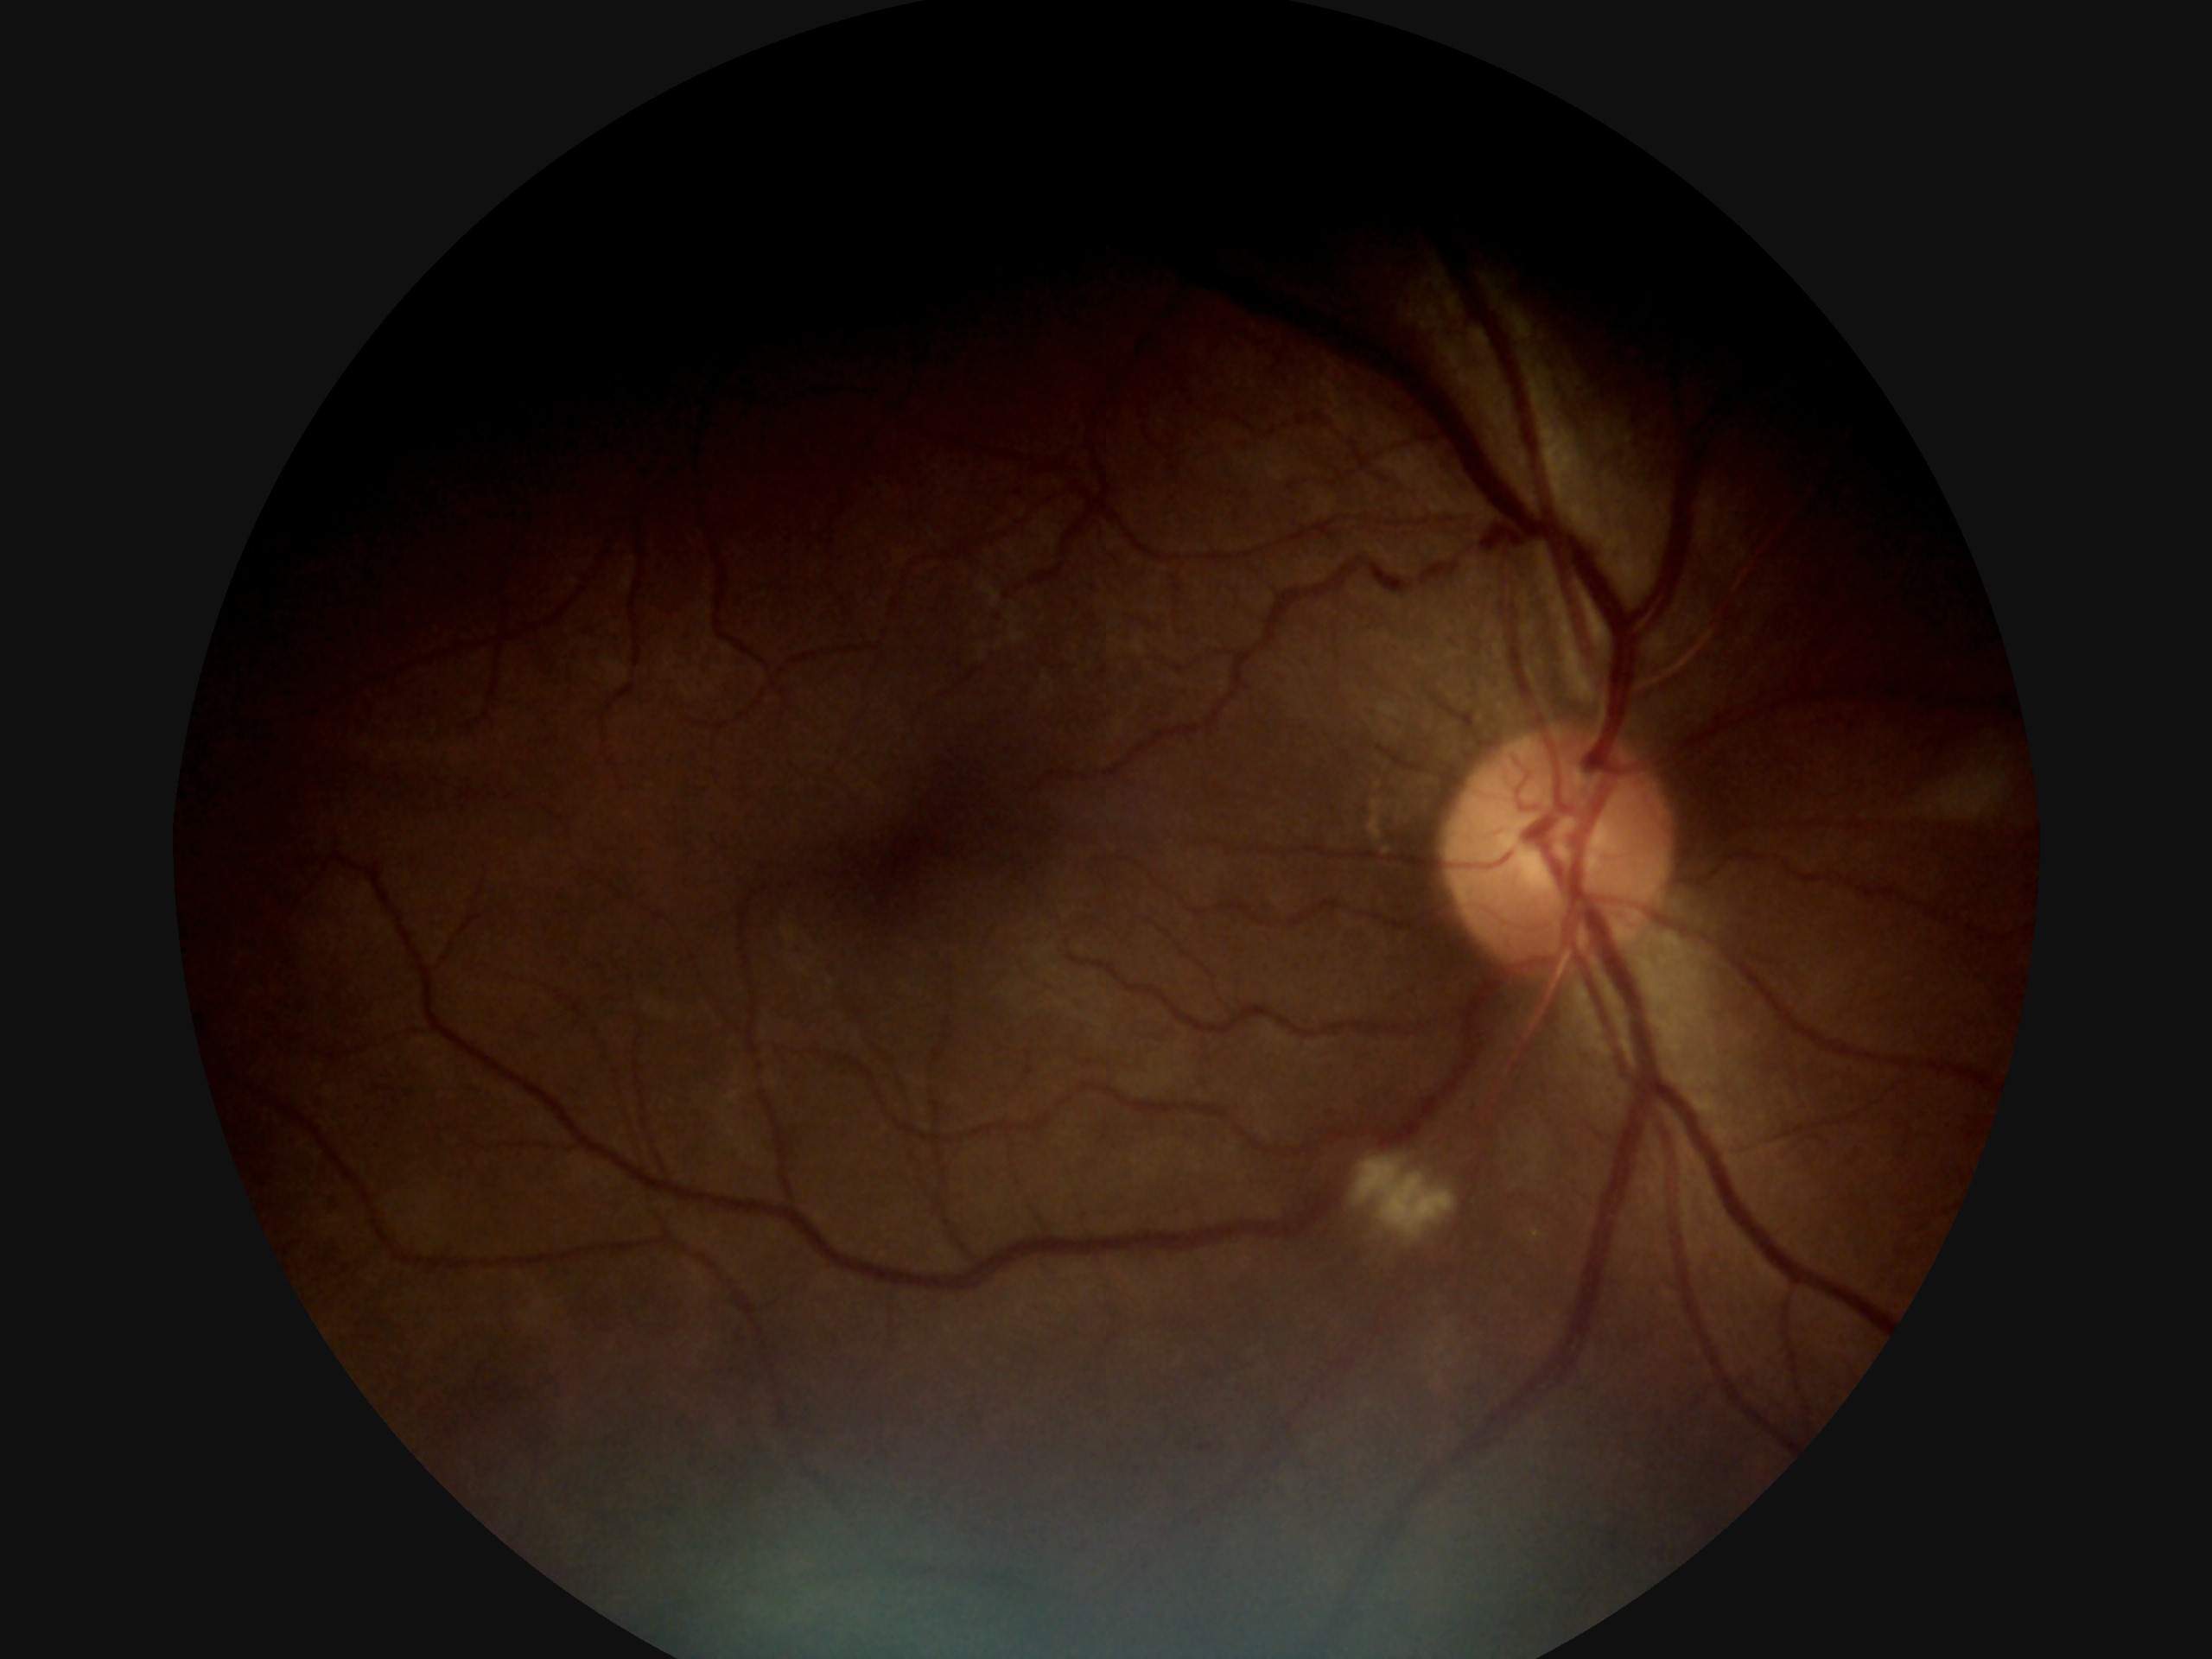 diabetic retinopathy grade@2 (moderate NPDR) — more than just microaneurysms but less than severe NPDR, DR class@non-proliferative diabetic retinopathy.